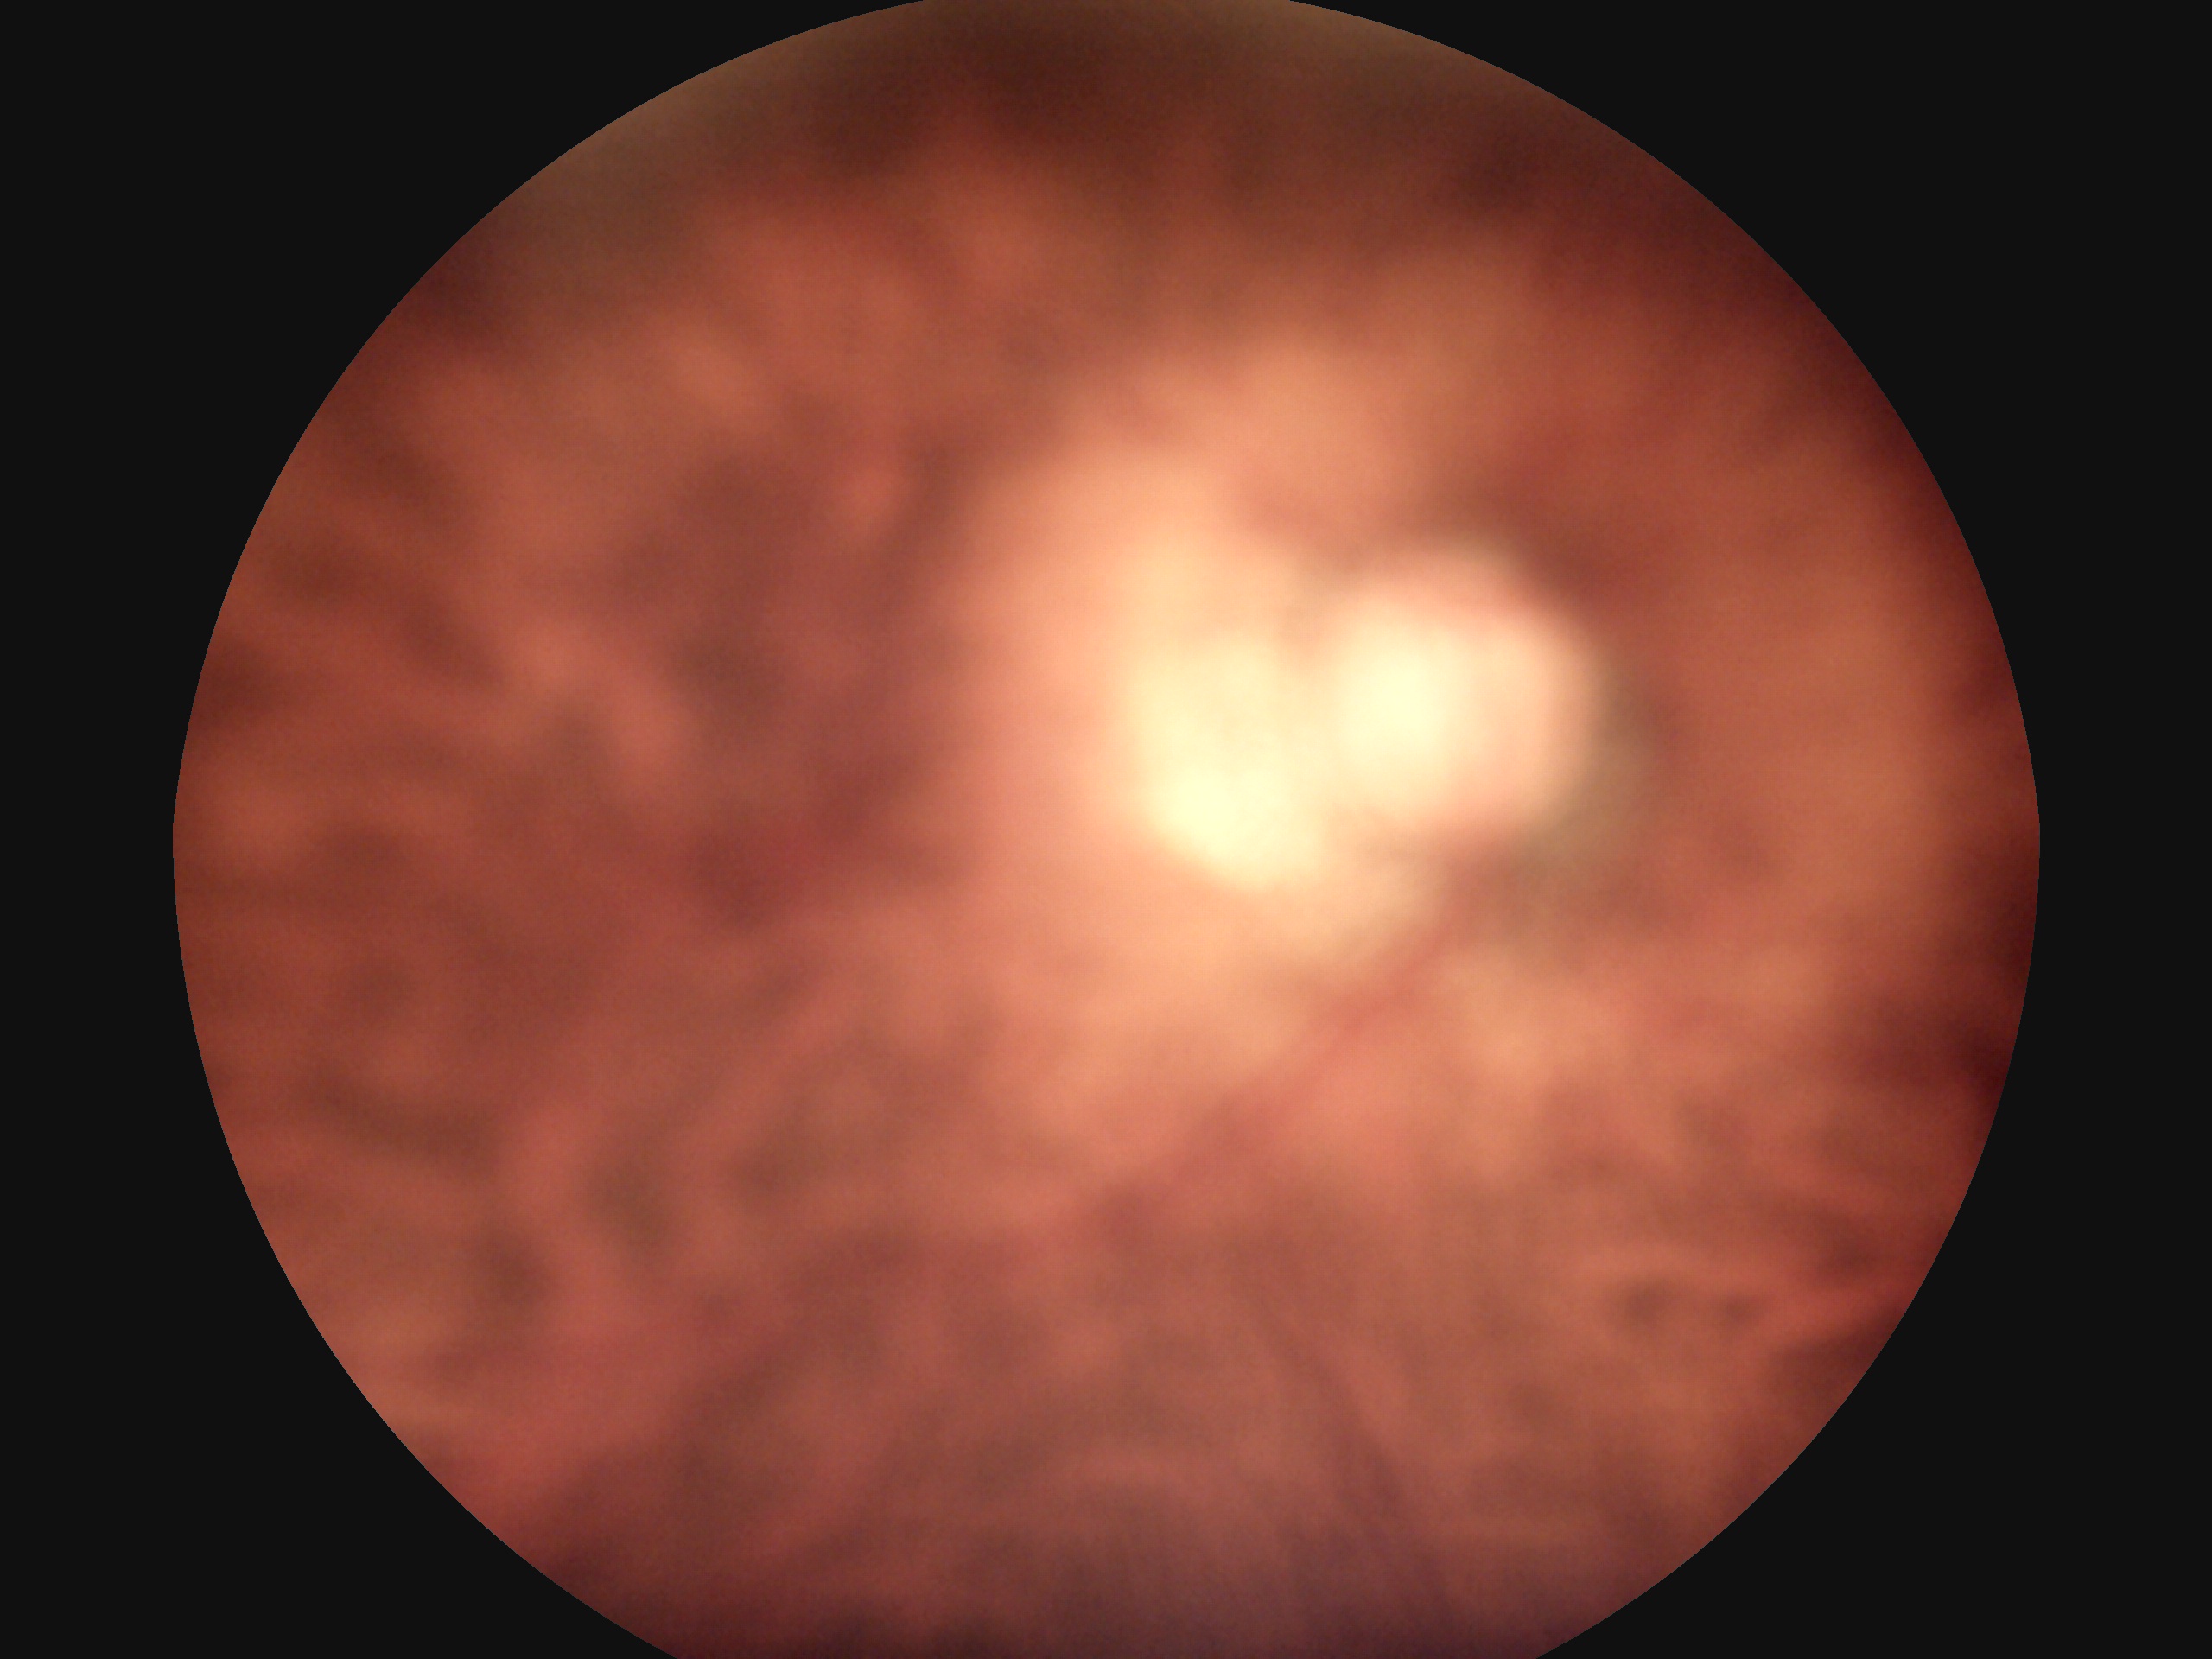 Retinopathy grade is ungradable due to poor image quality.